Retinal fundus photograph
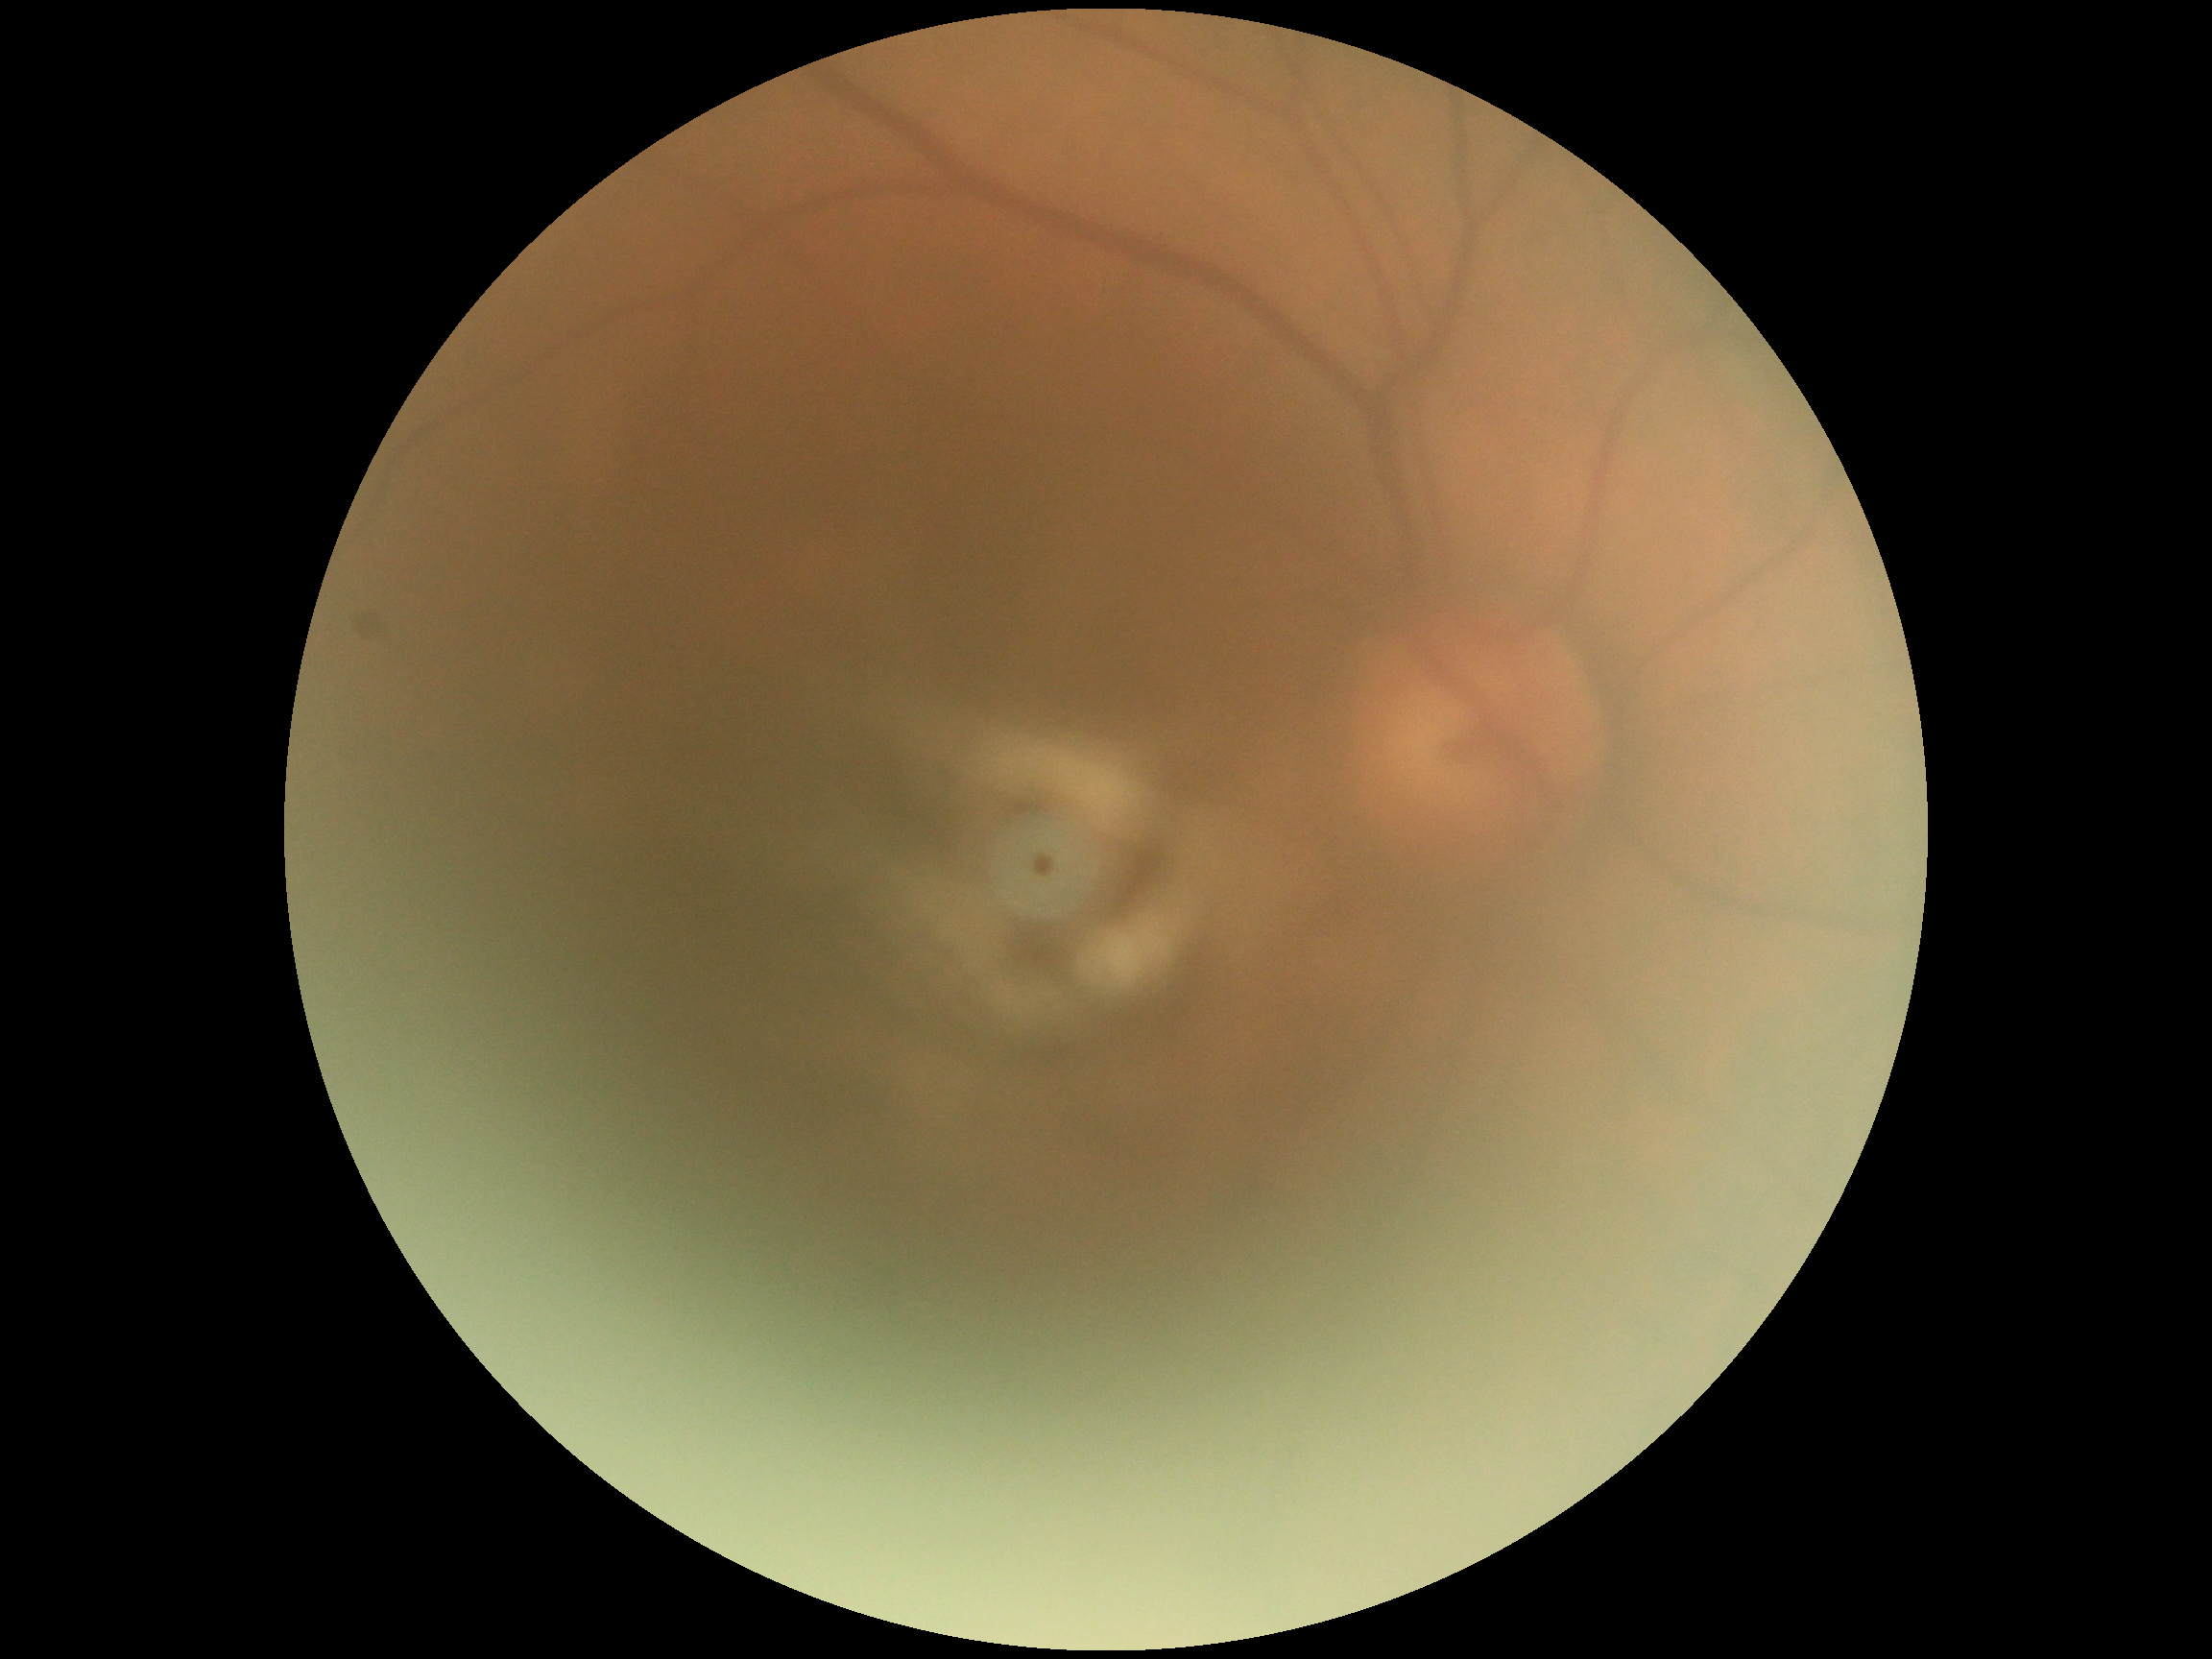

DR grade is ungradable. Quality too poor to assess for DR.